2228 x 1652 pixels:
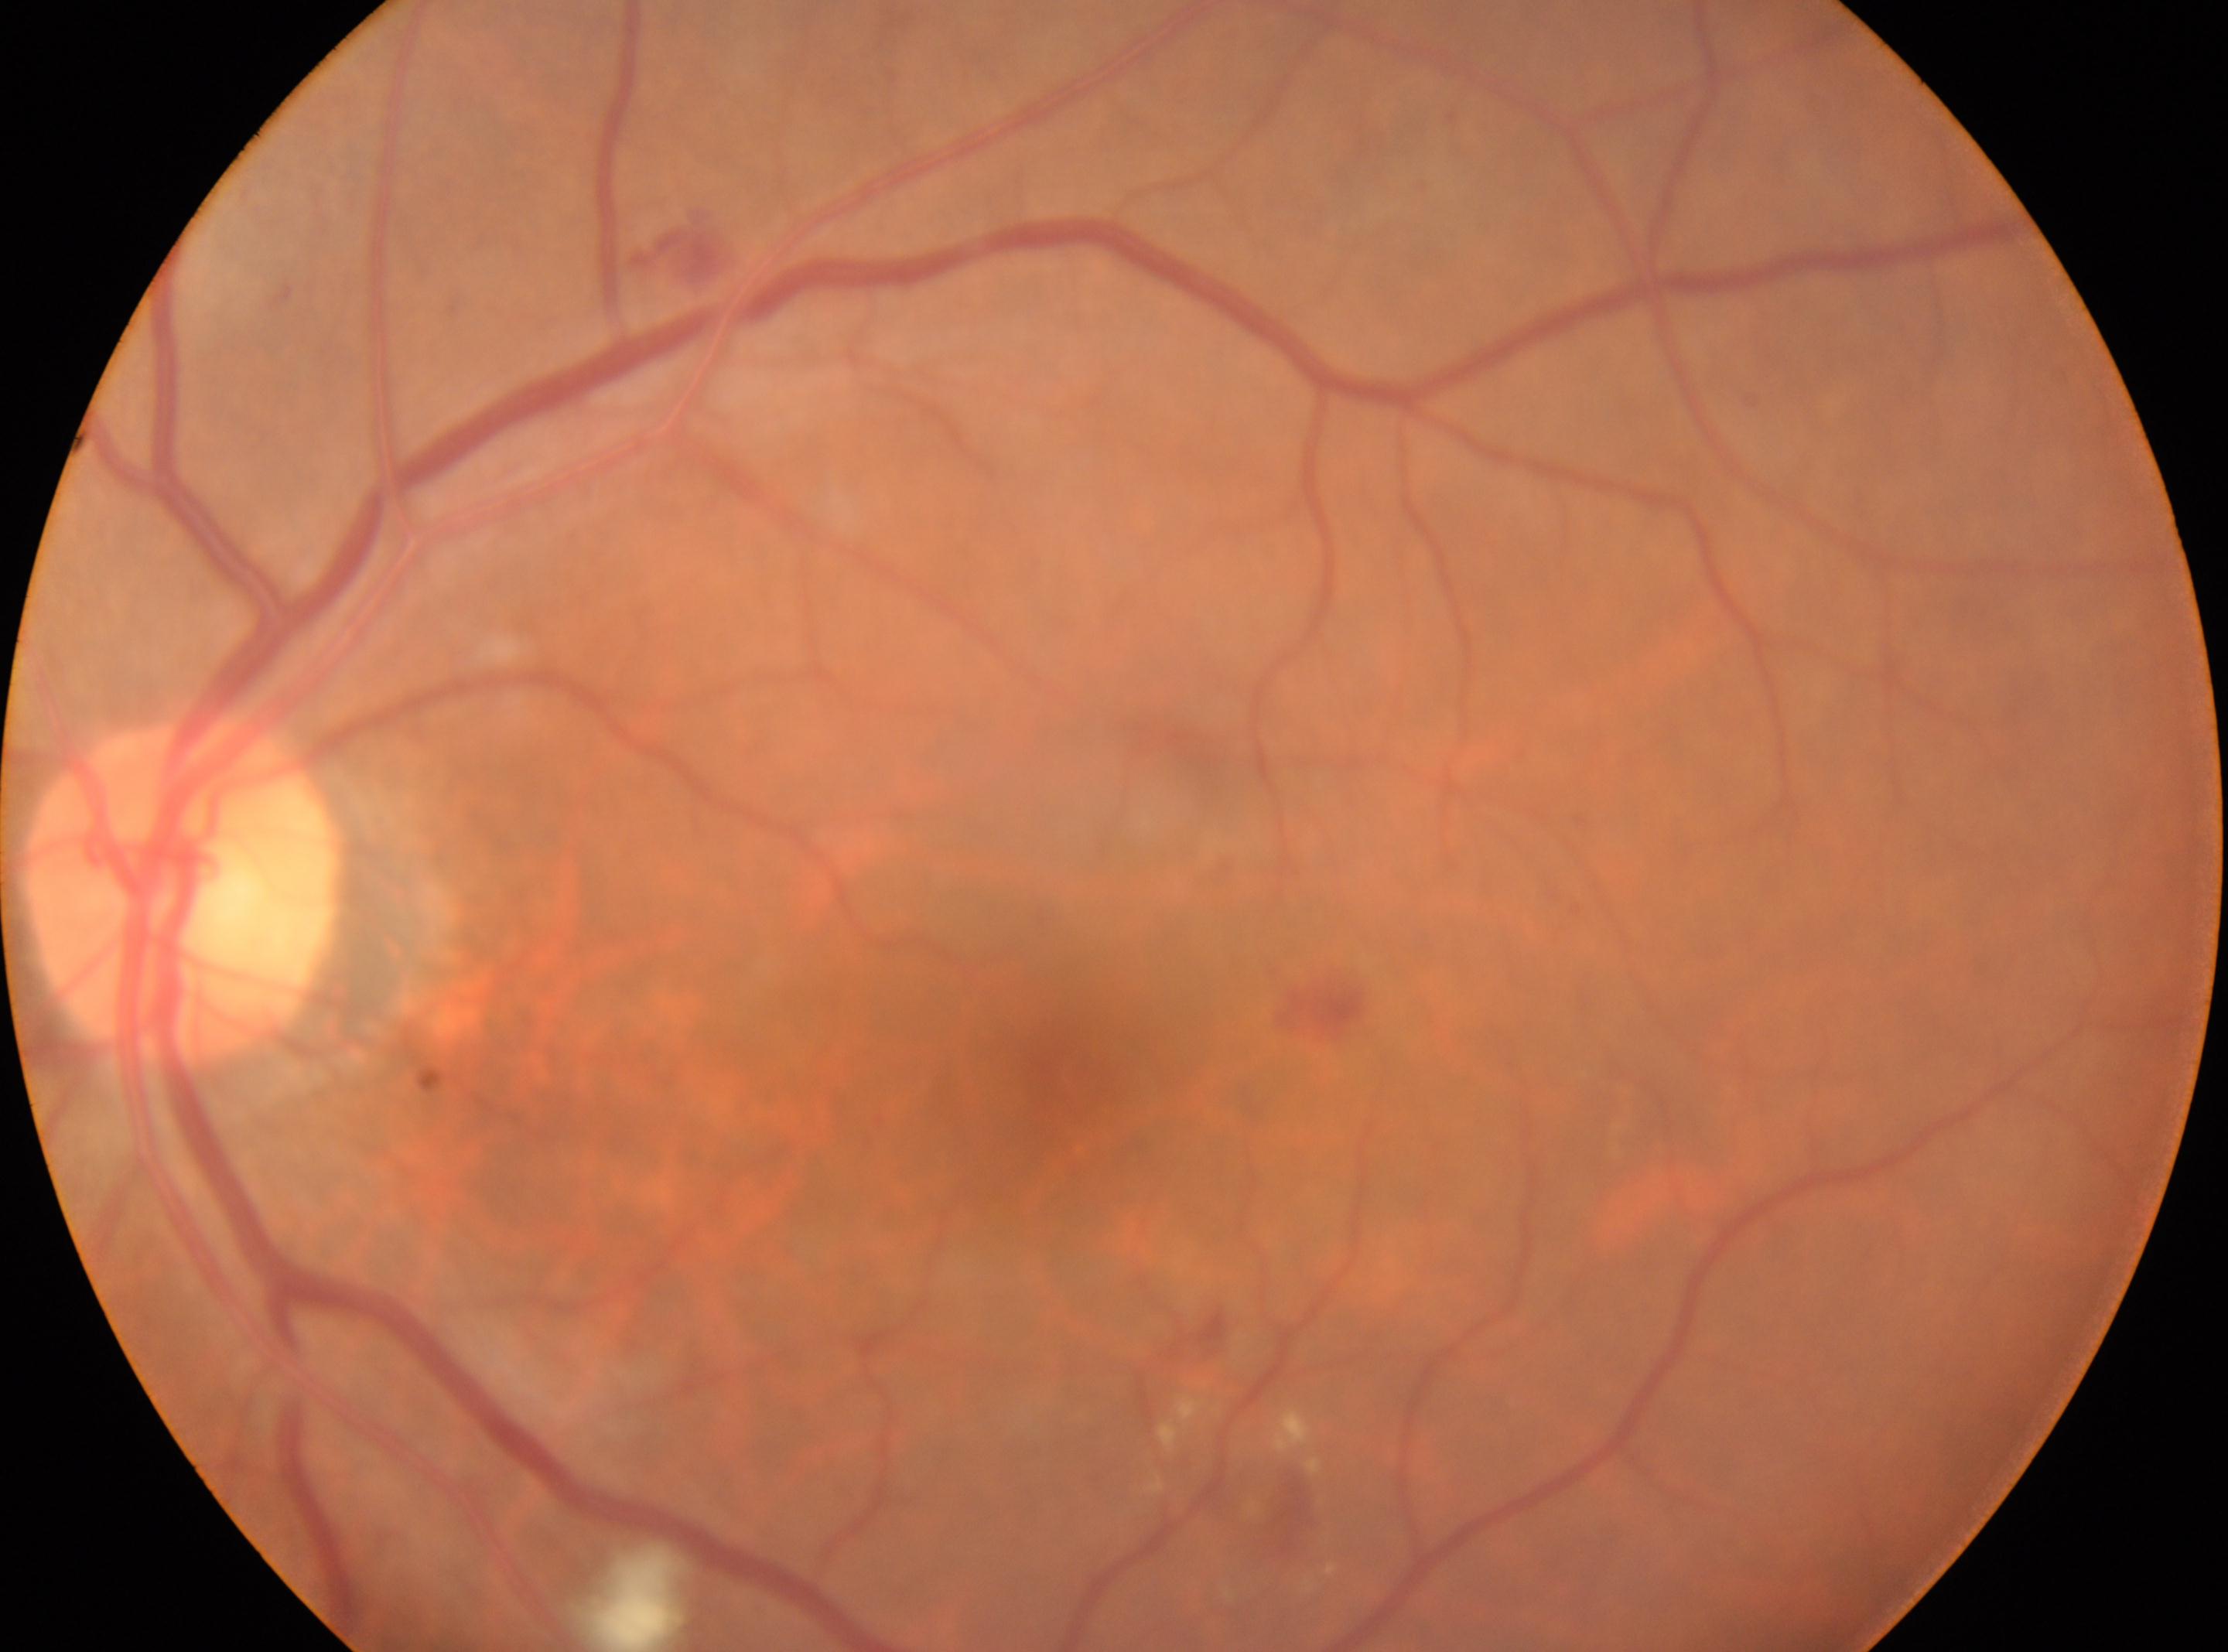
{
  "optic_disc": "(179,886)",
  "eye": "left eye",
  "fovea": "(1074,1087)",
  "dr_grade": "2"
}